Image size 640x480; pediatric retinal photograph (wide-field).
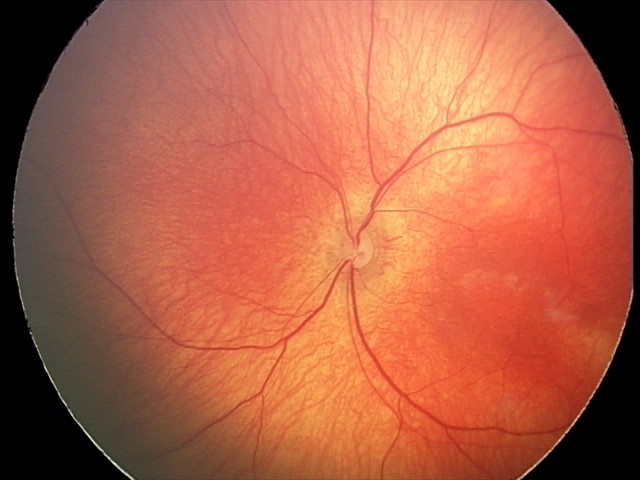

Physiological retinal appearance for postconceptual age.